Graded on the modified Davis scale. Camera: NIDEK AFC-230 — 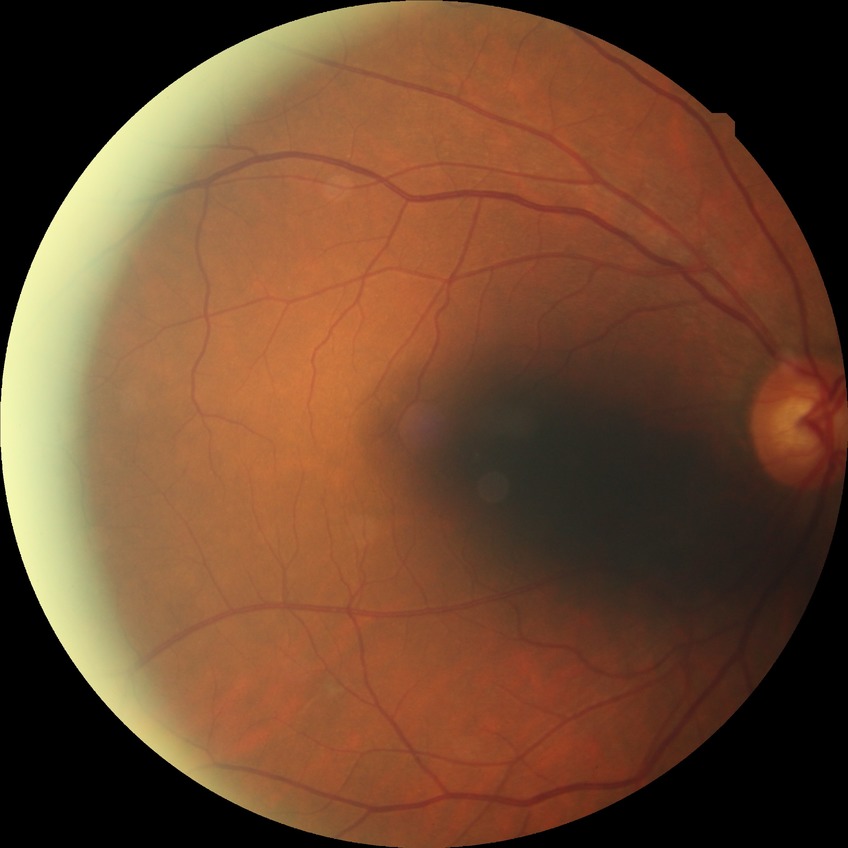 diabetic retinopathy (DR): no diabetic retinopathy (NDR).